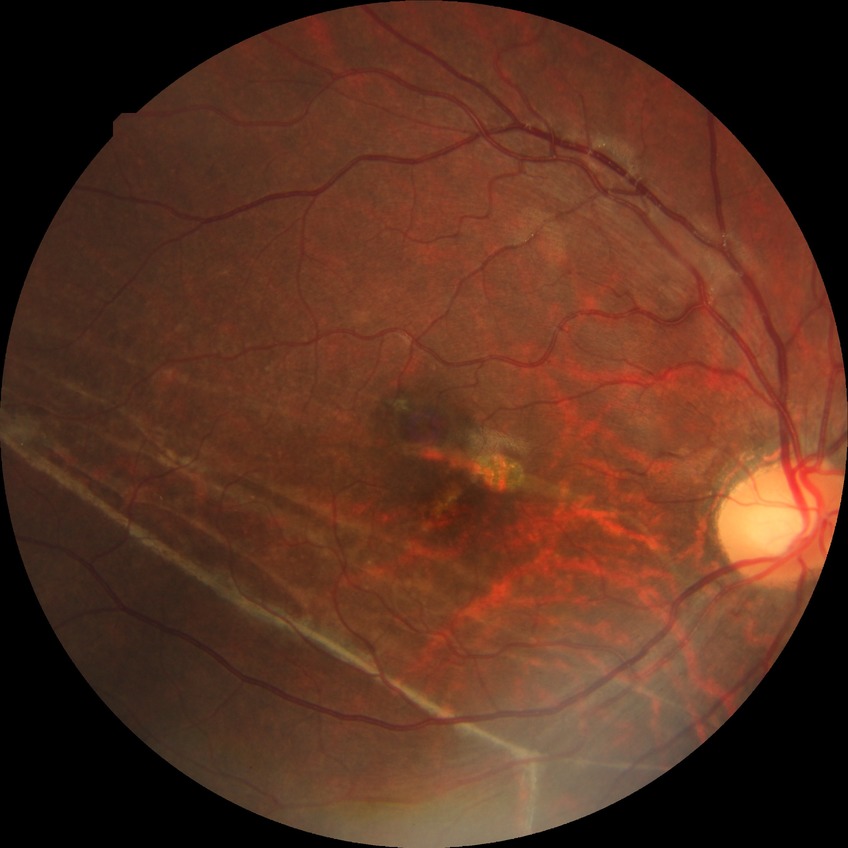
Assessment:
* DR: NDR